240 x 240 pixels
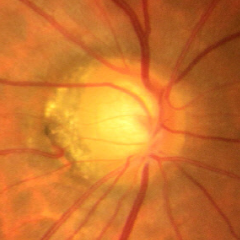 Optic disc appearance consistent with early glaucomatous optic neuropathy.